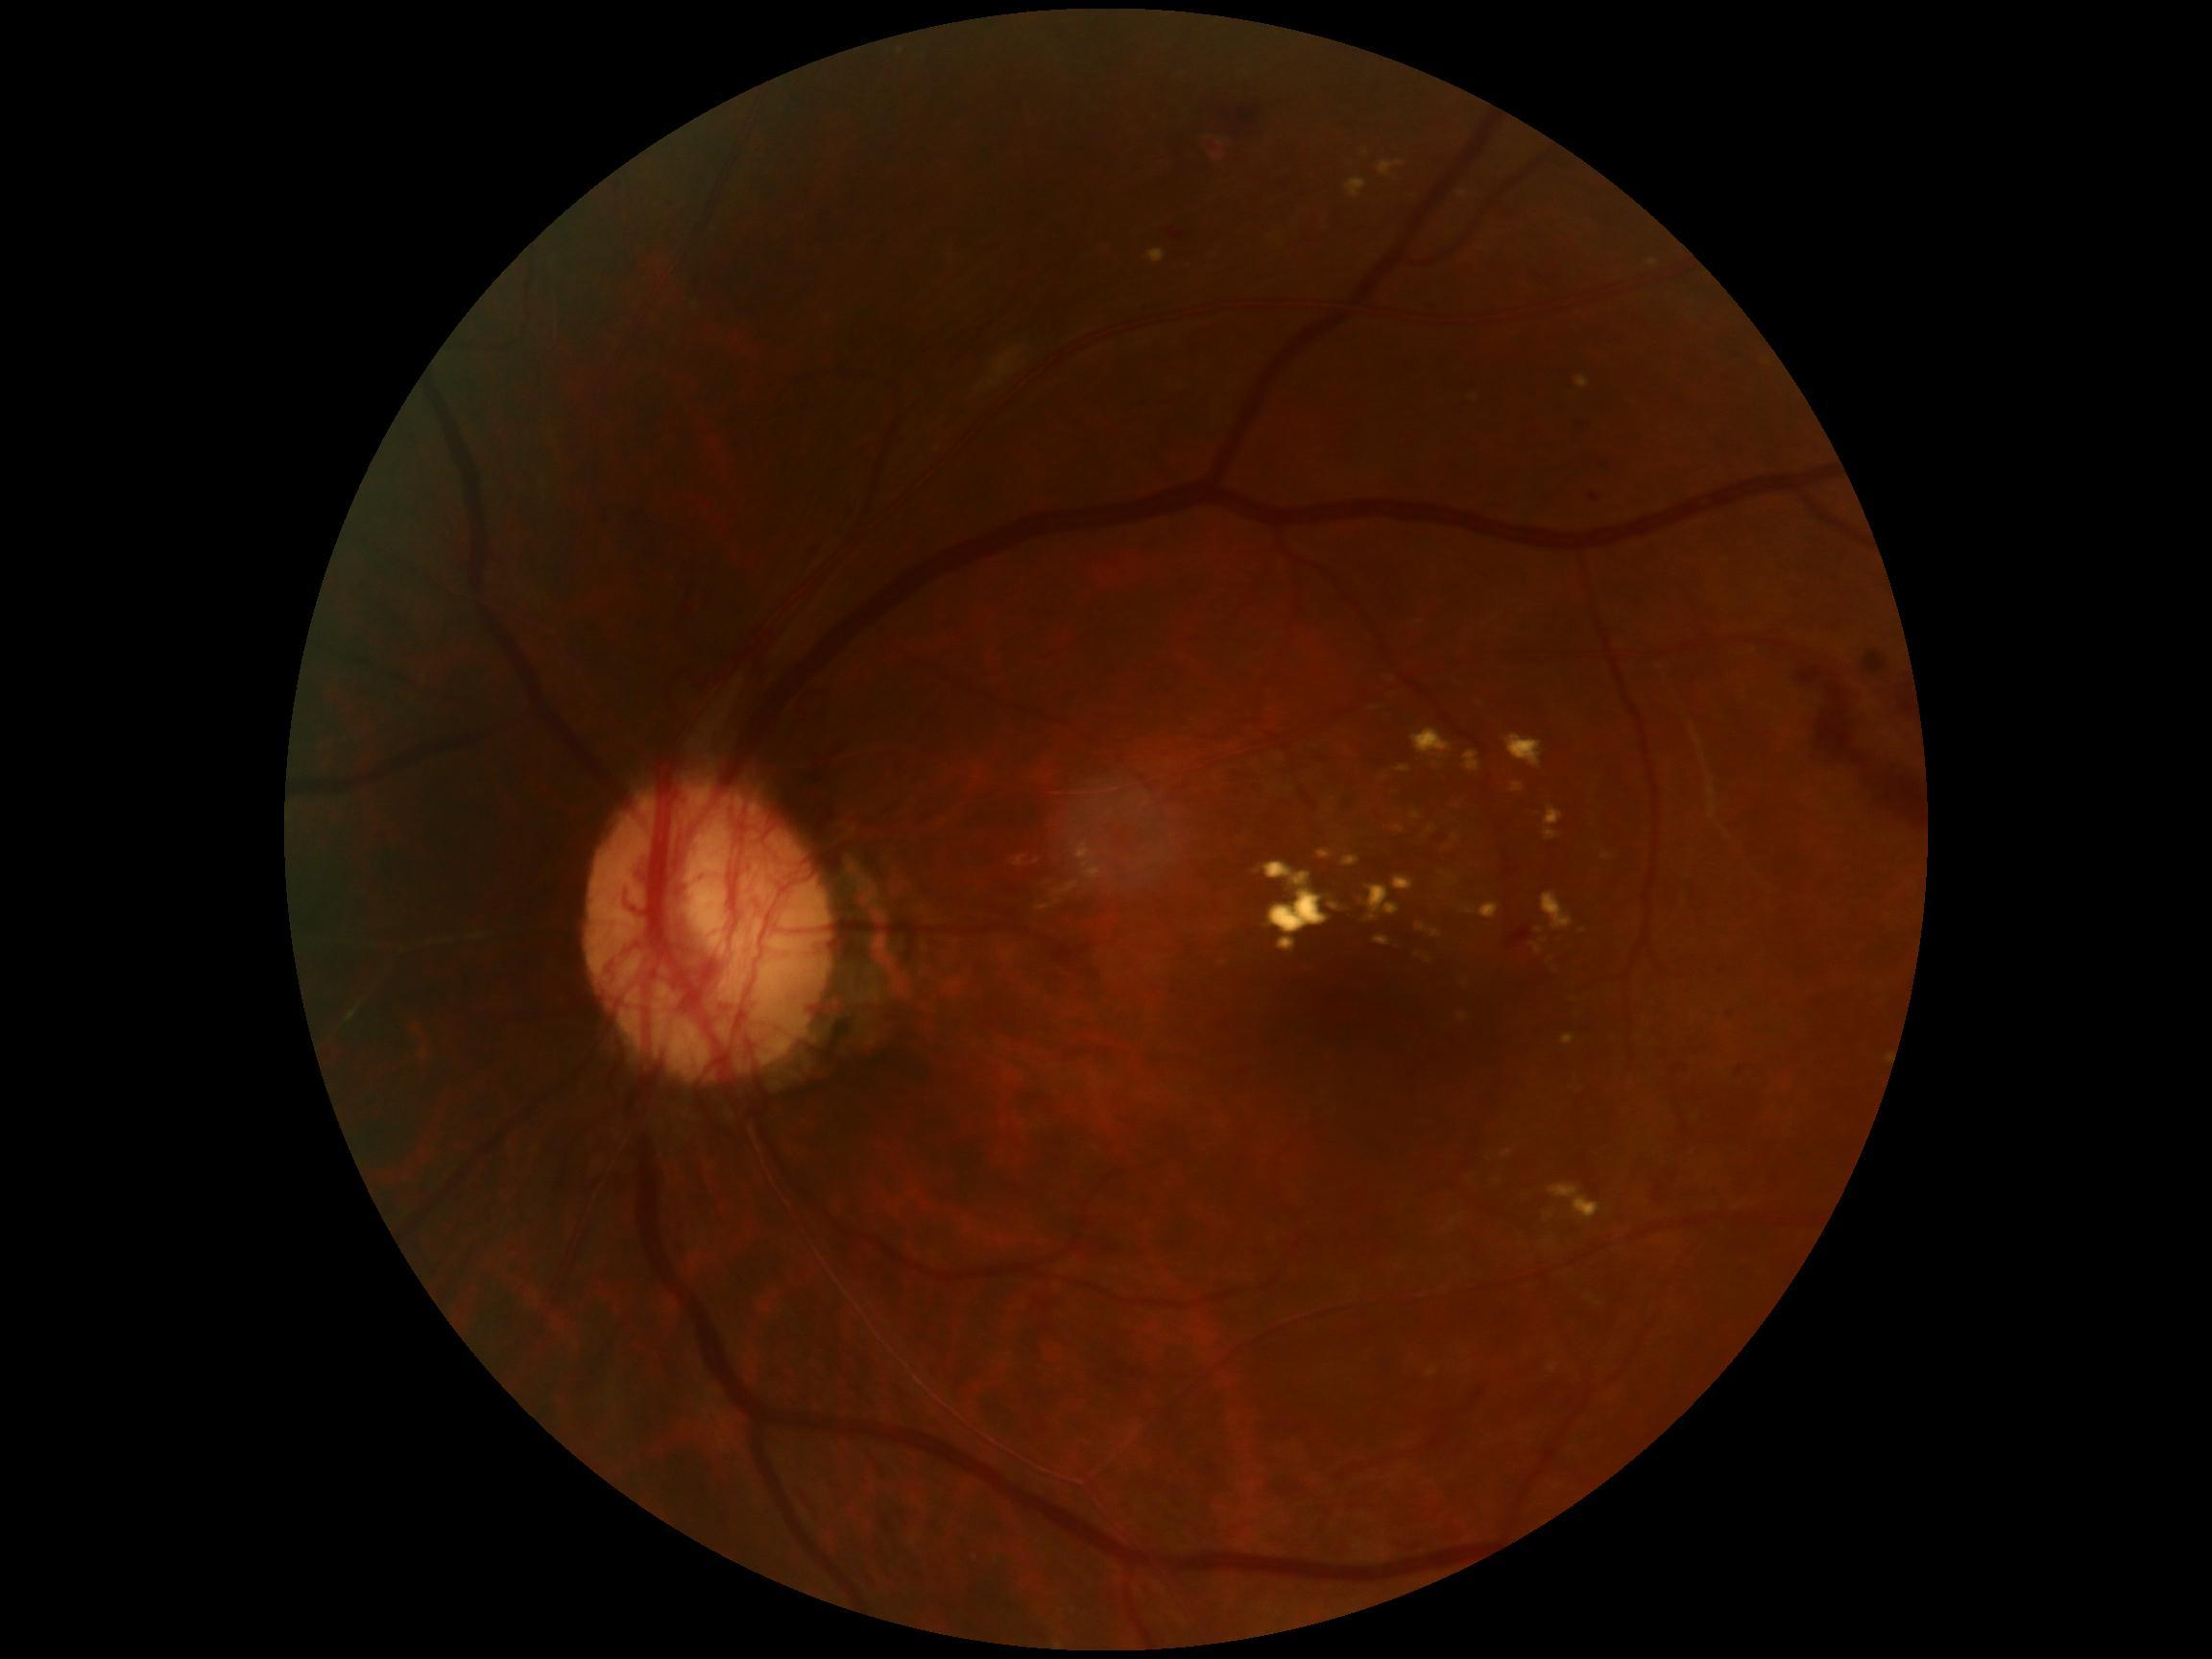

Annotations:
- DR class: proliferative diabetic retinopathy
- diabetic retinopathy (DR): grade 4